NIDEK AFC-230 fundus camera. 848 x 848 pixels. 45-degree field of view: 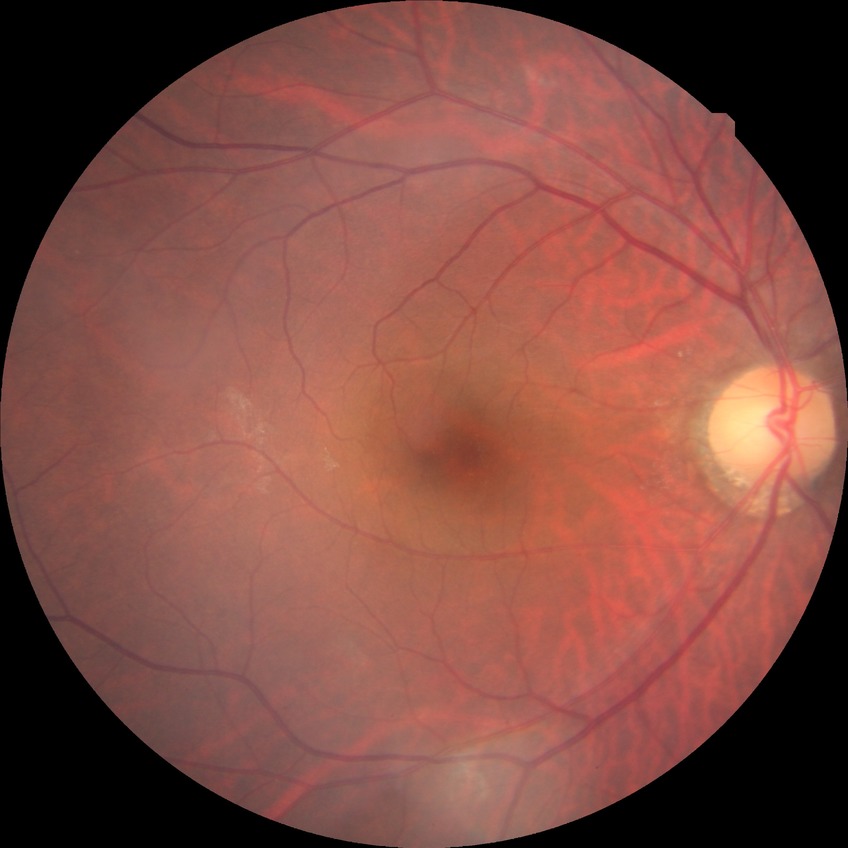
diabetic retinopathy (DR): no diabetic retinopathy (NDR)